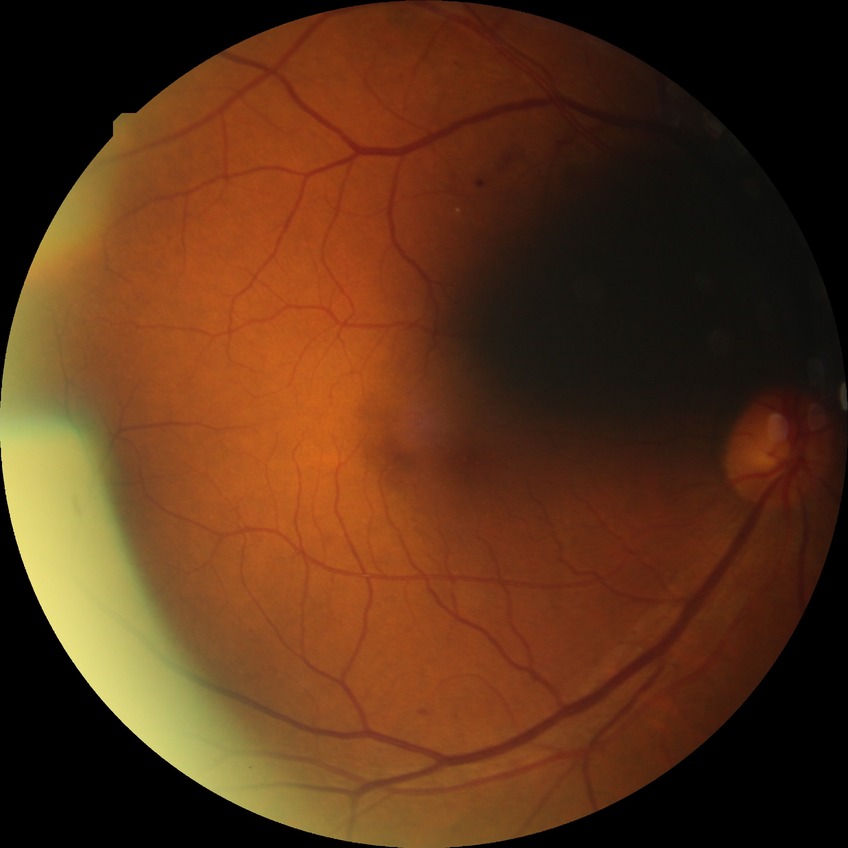
  davis_grade: simple diabetic retinopathy